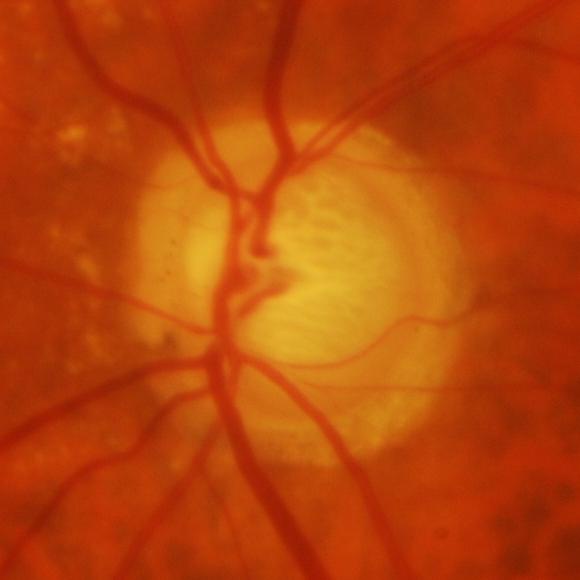
Finding = glaucomatous changes.